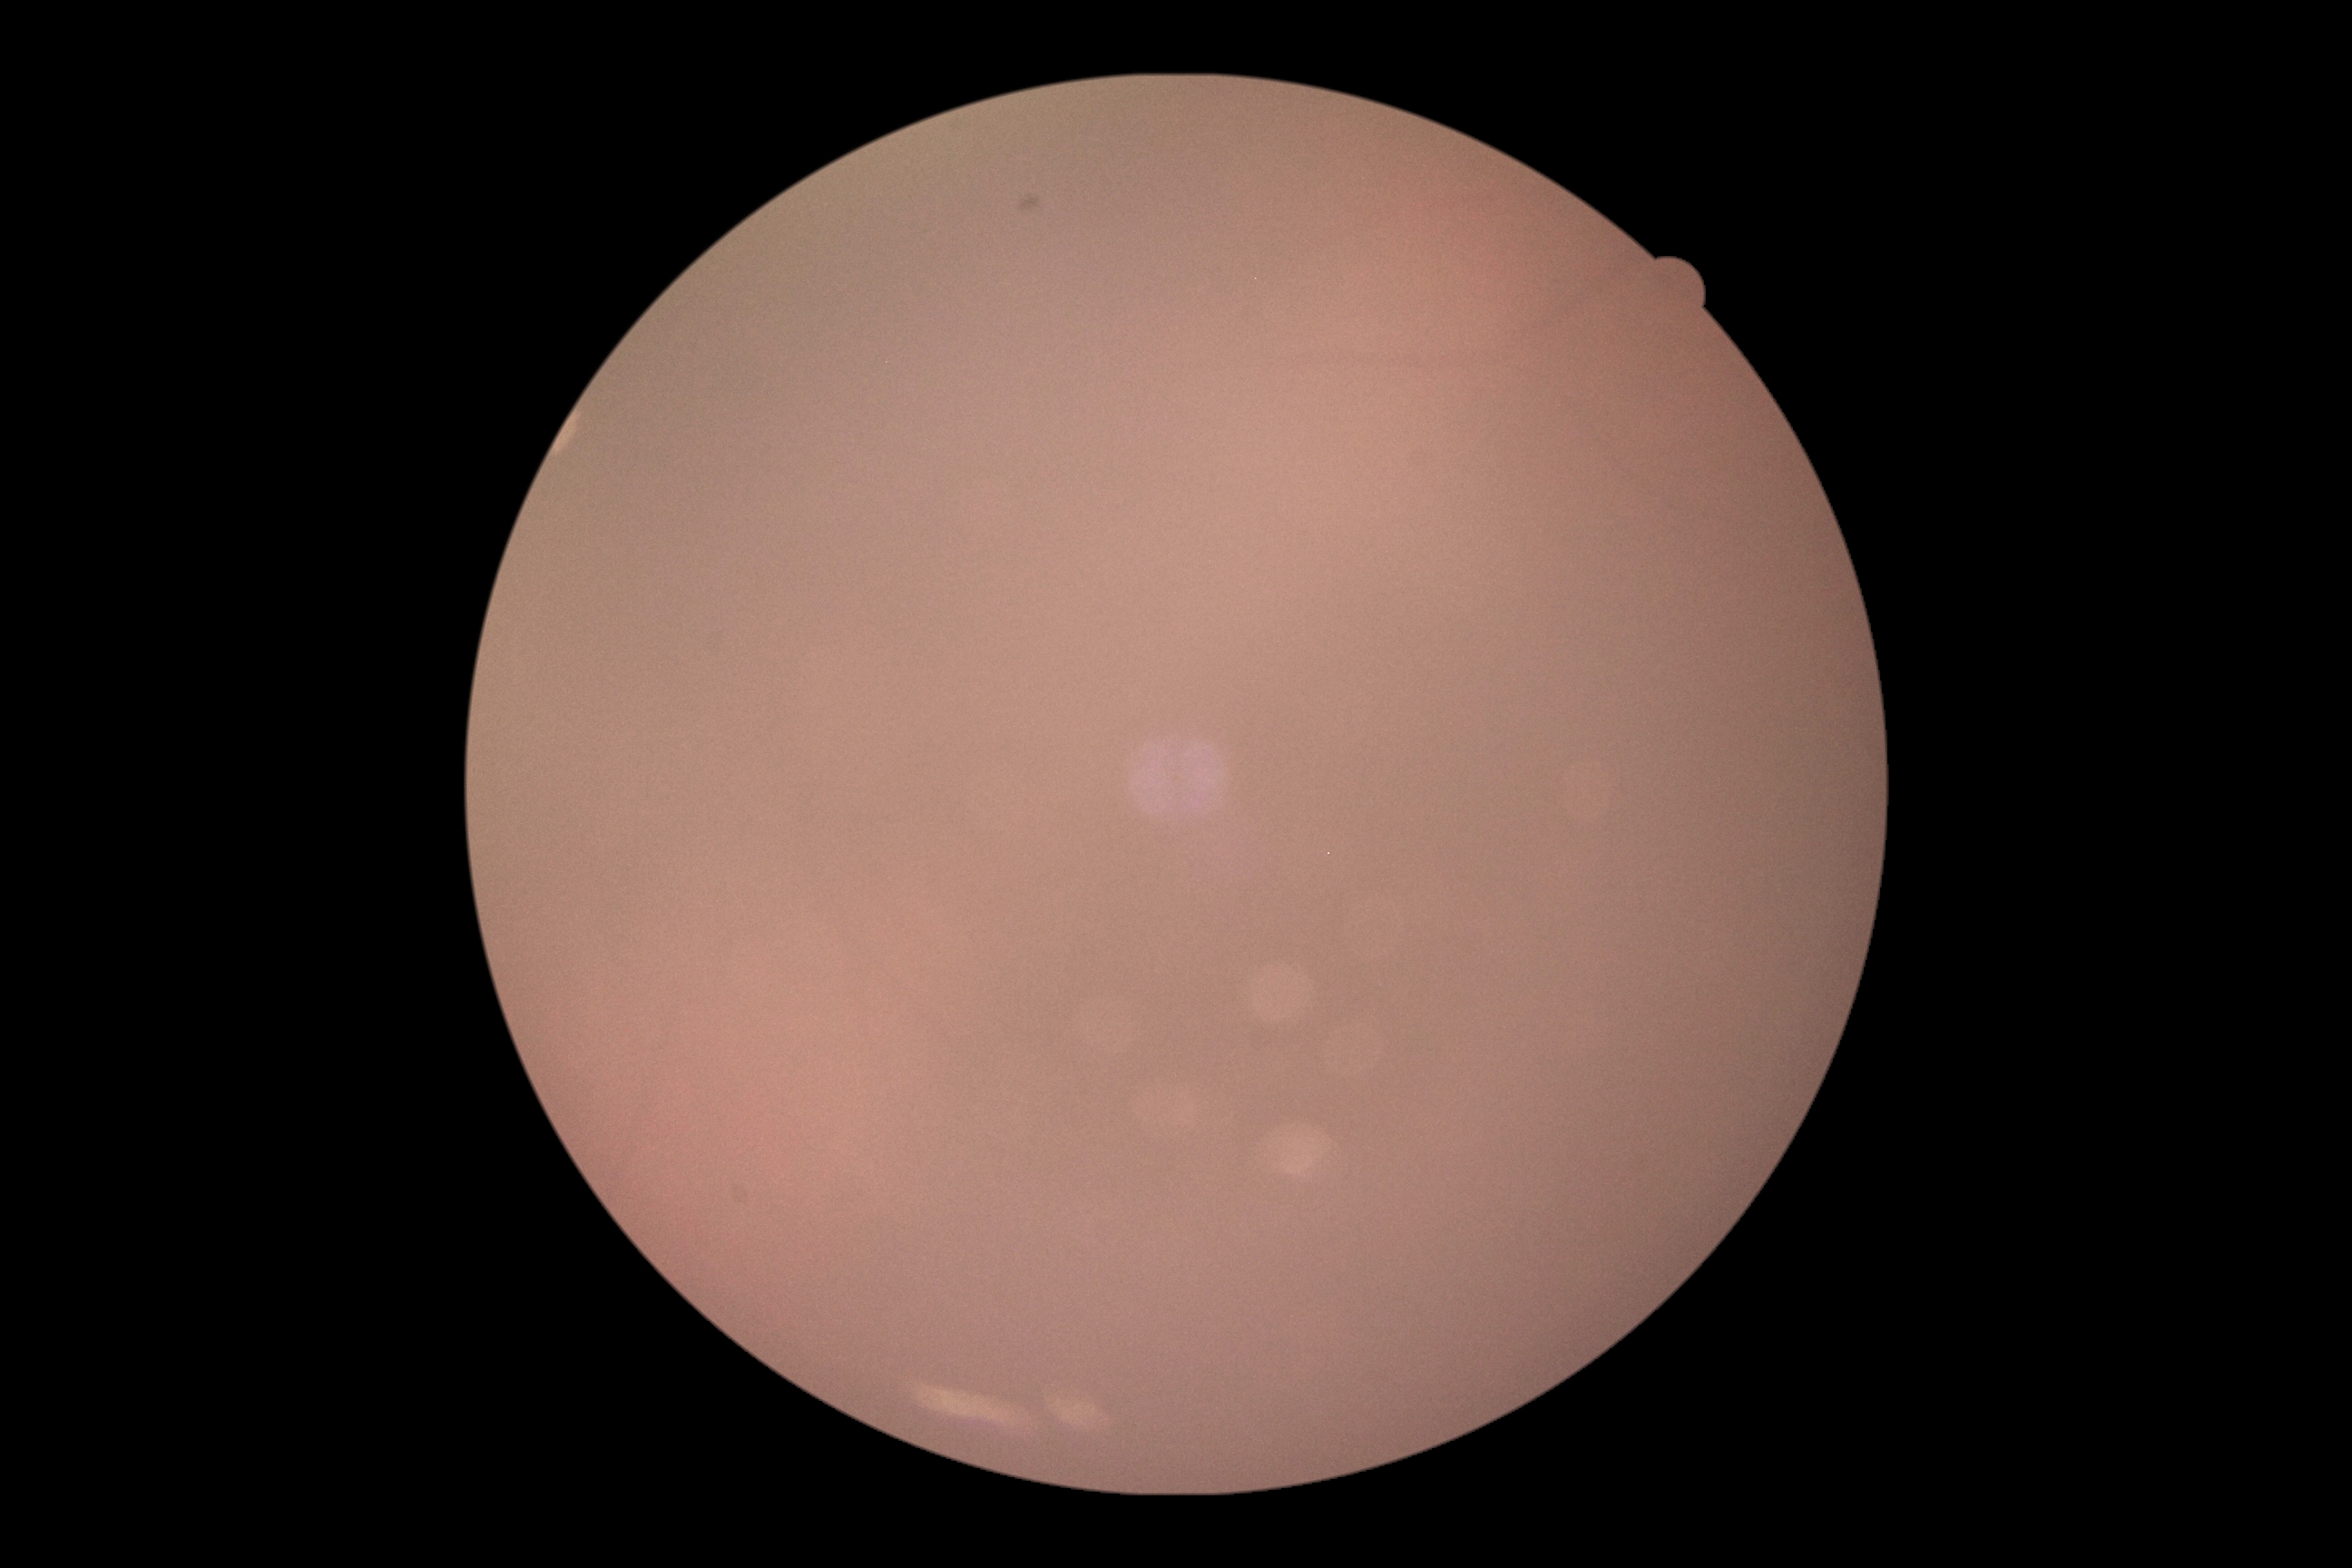
Image quality is insufficient for diabetic retinopathy assessment. Retinopathy grade: ungradable due to poor image quality.